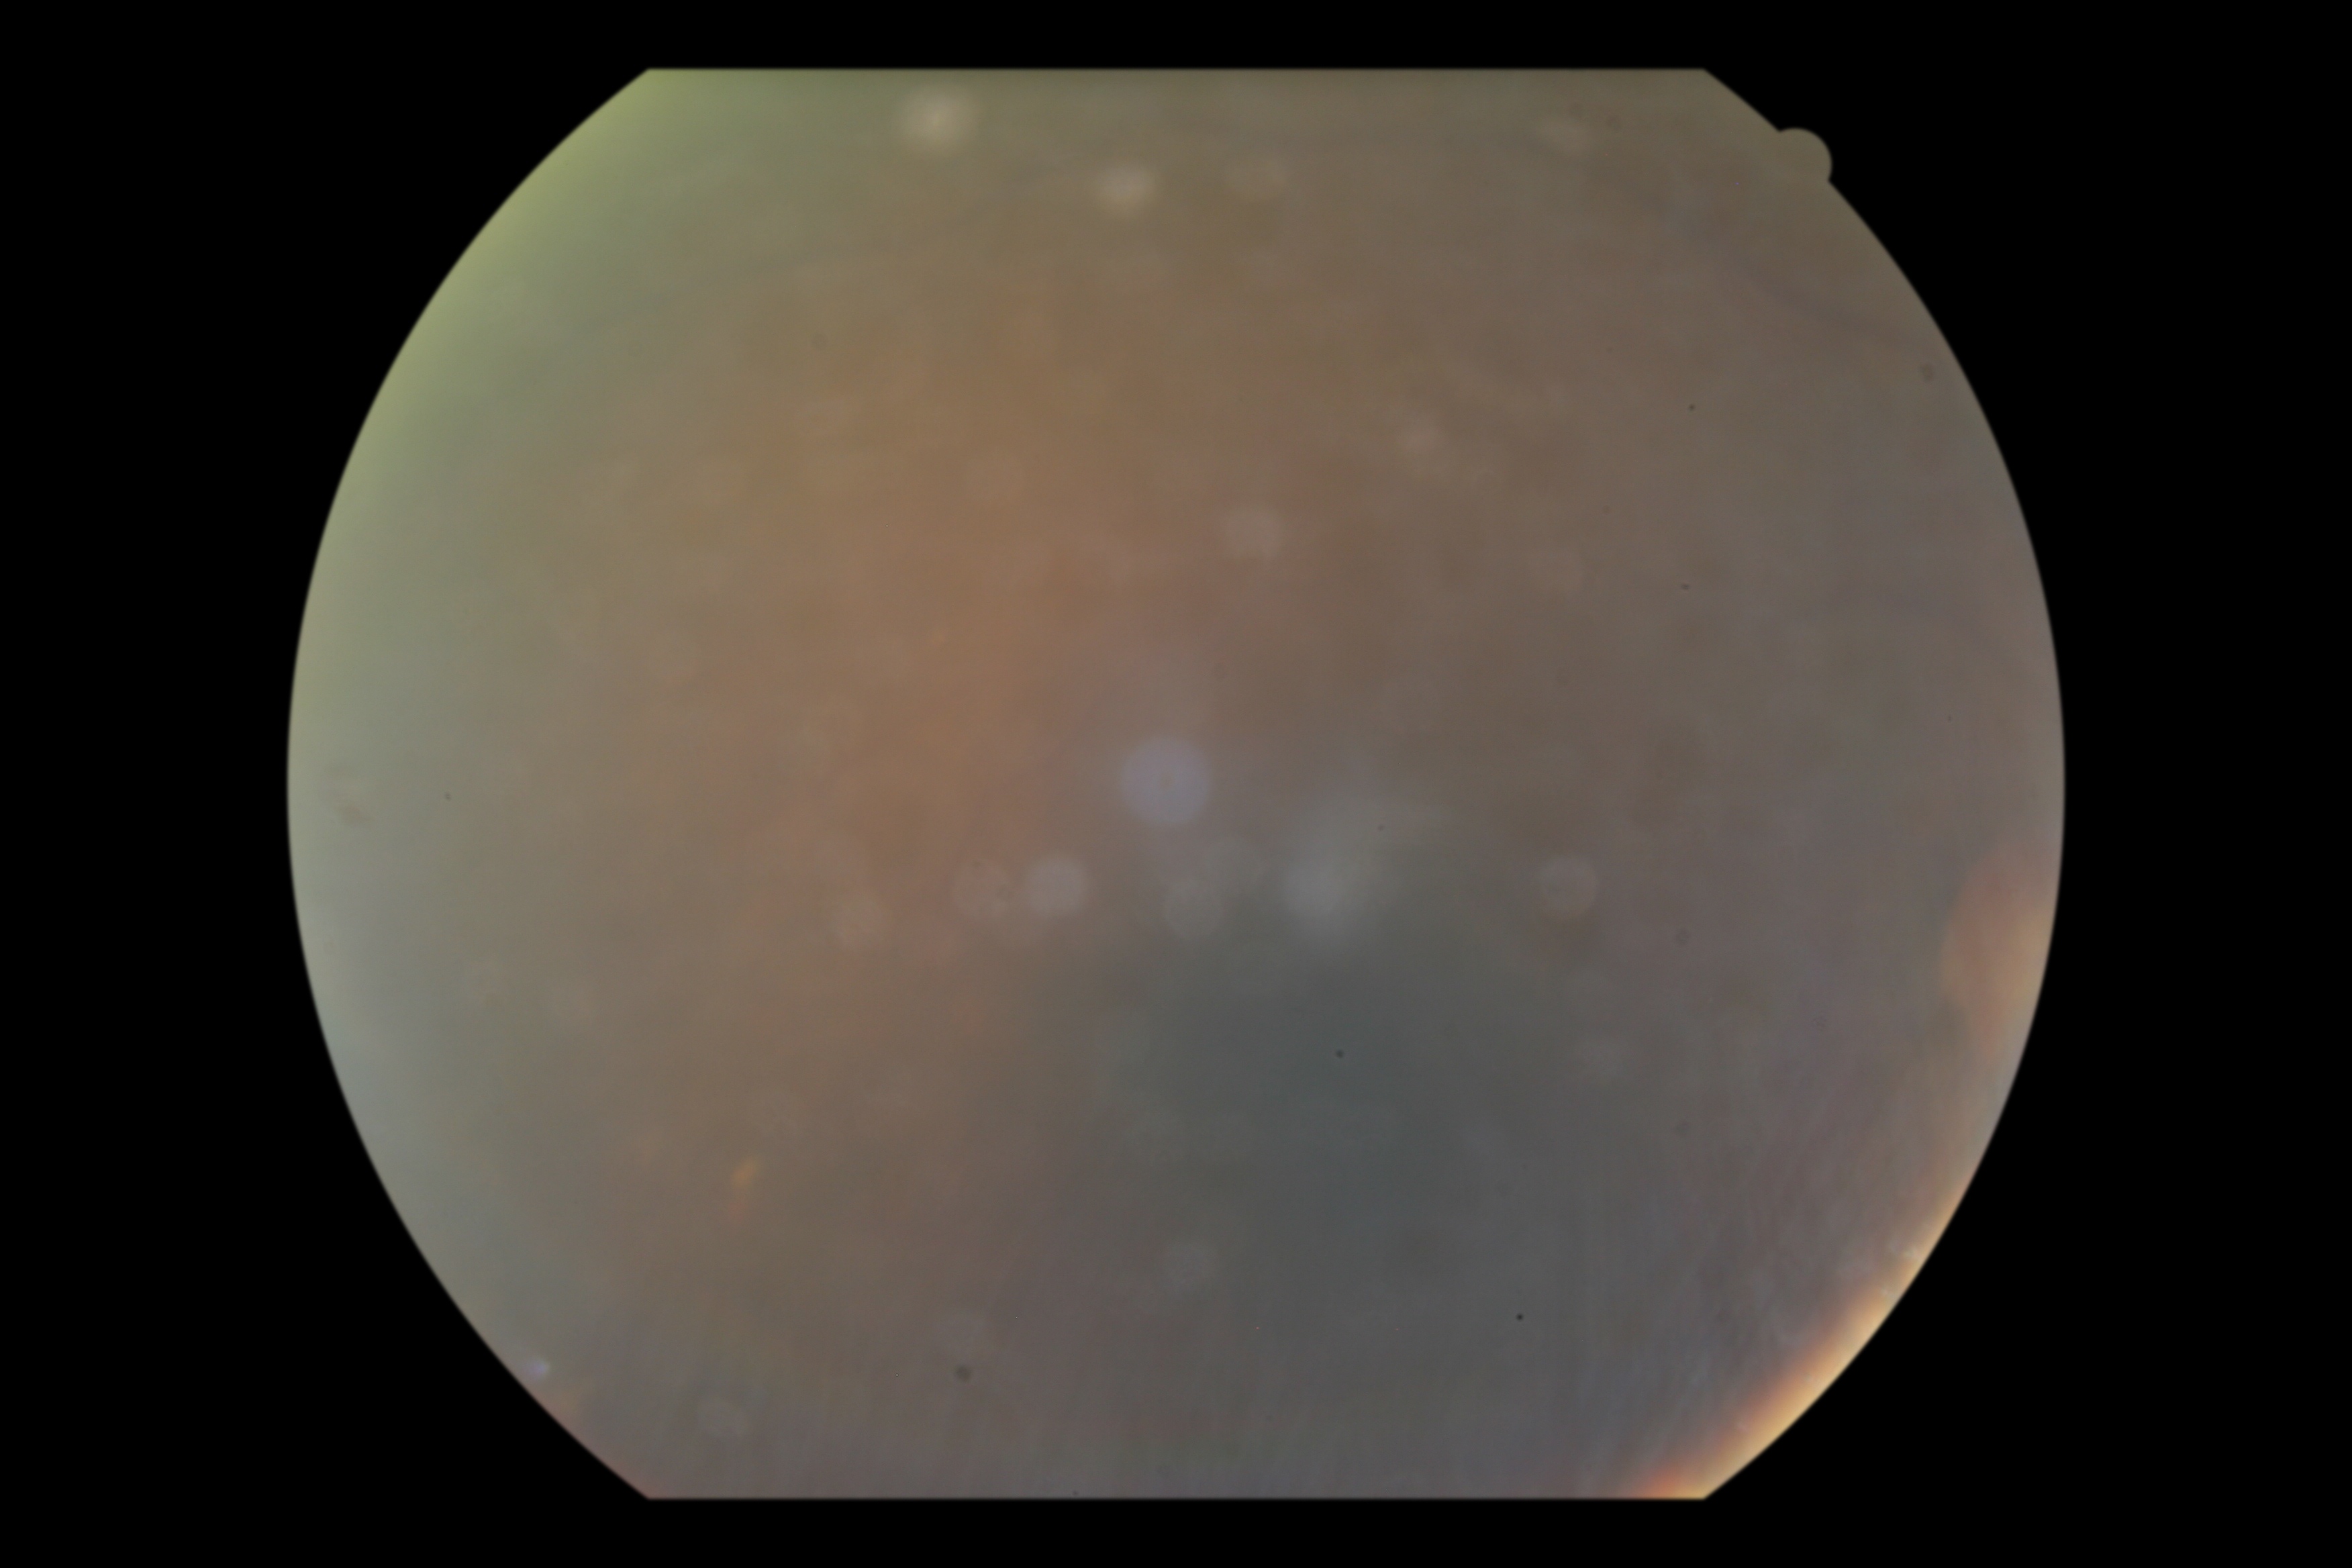

DR is ungradable due to poor image quality.